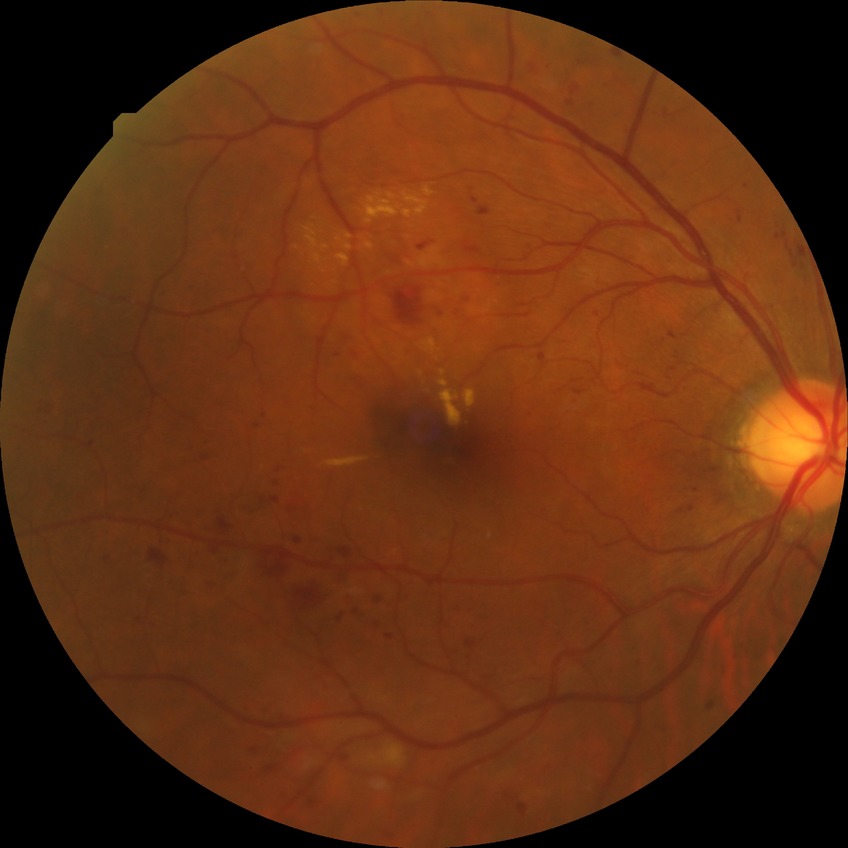
diabetic retinopathy (DR) = pre-proliferative diabetic retinopathy (PPDR).